Retinal fundus photograph
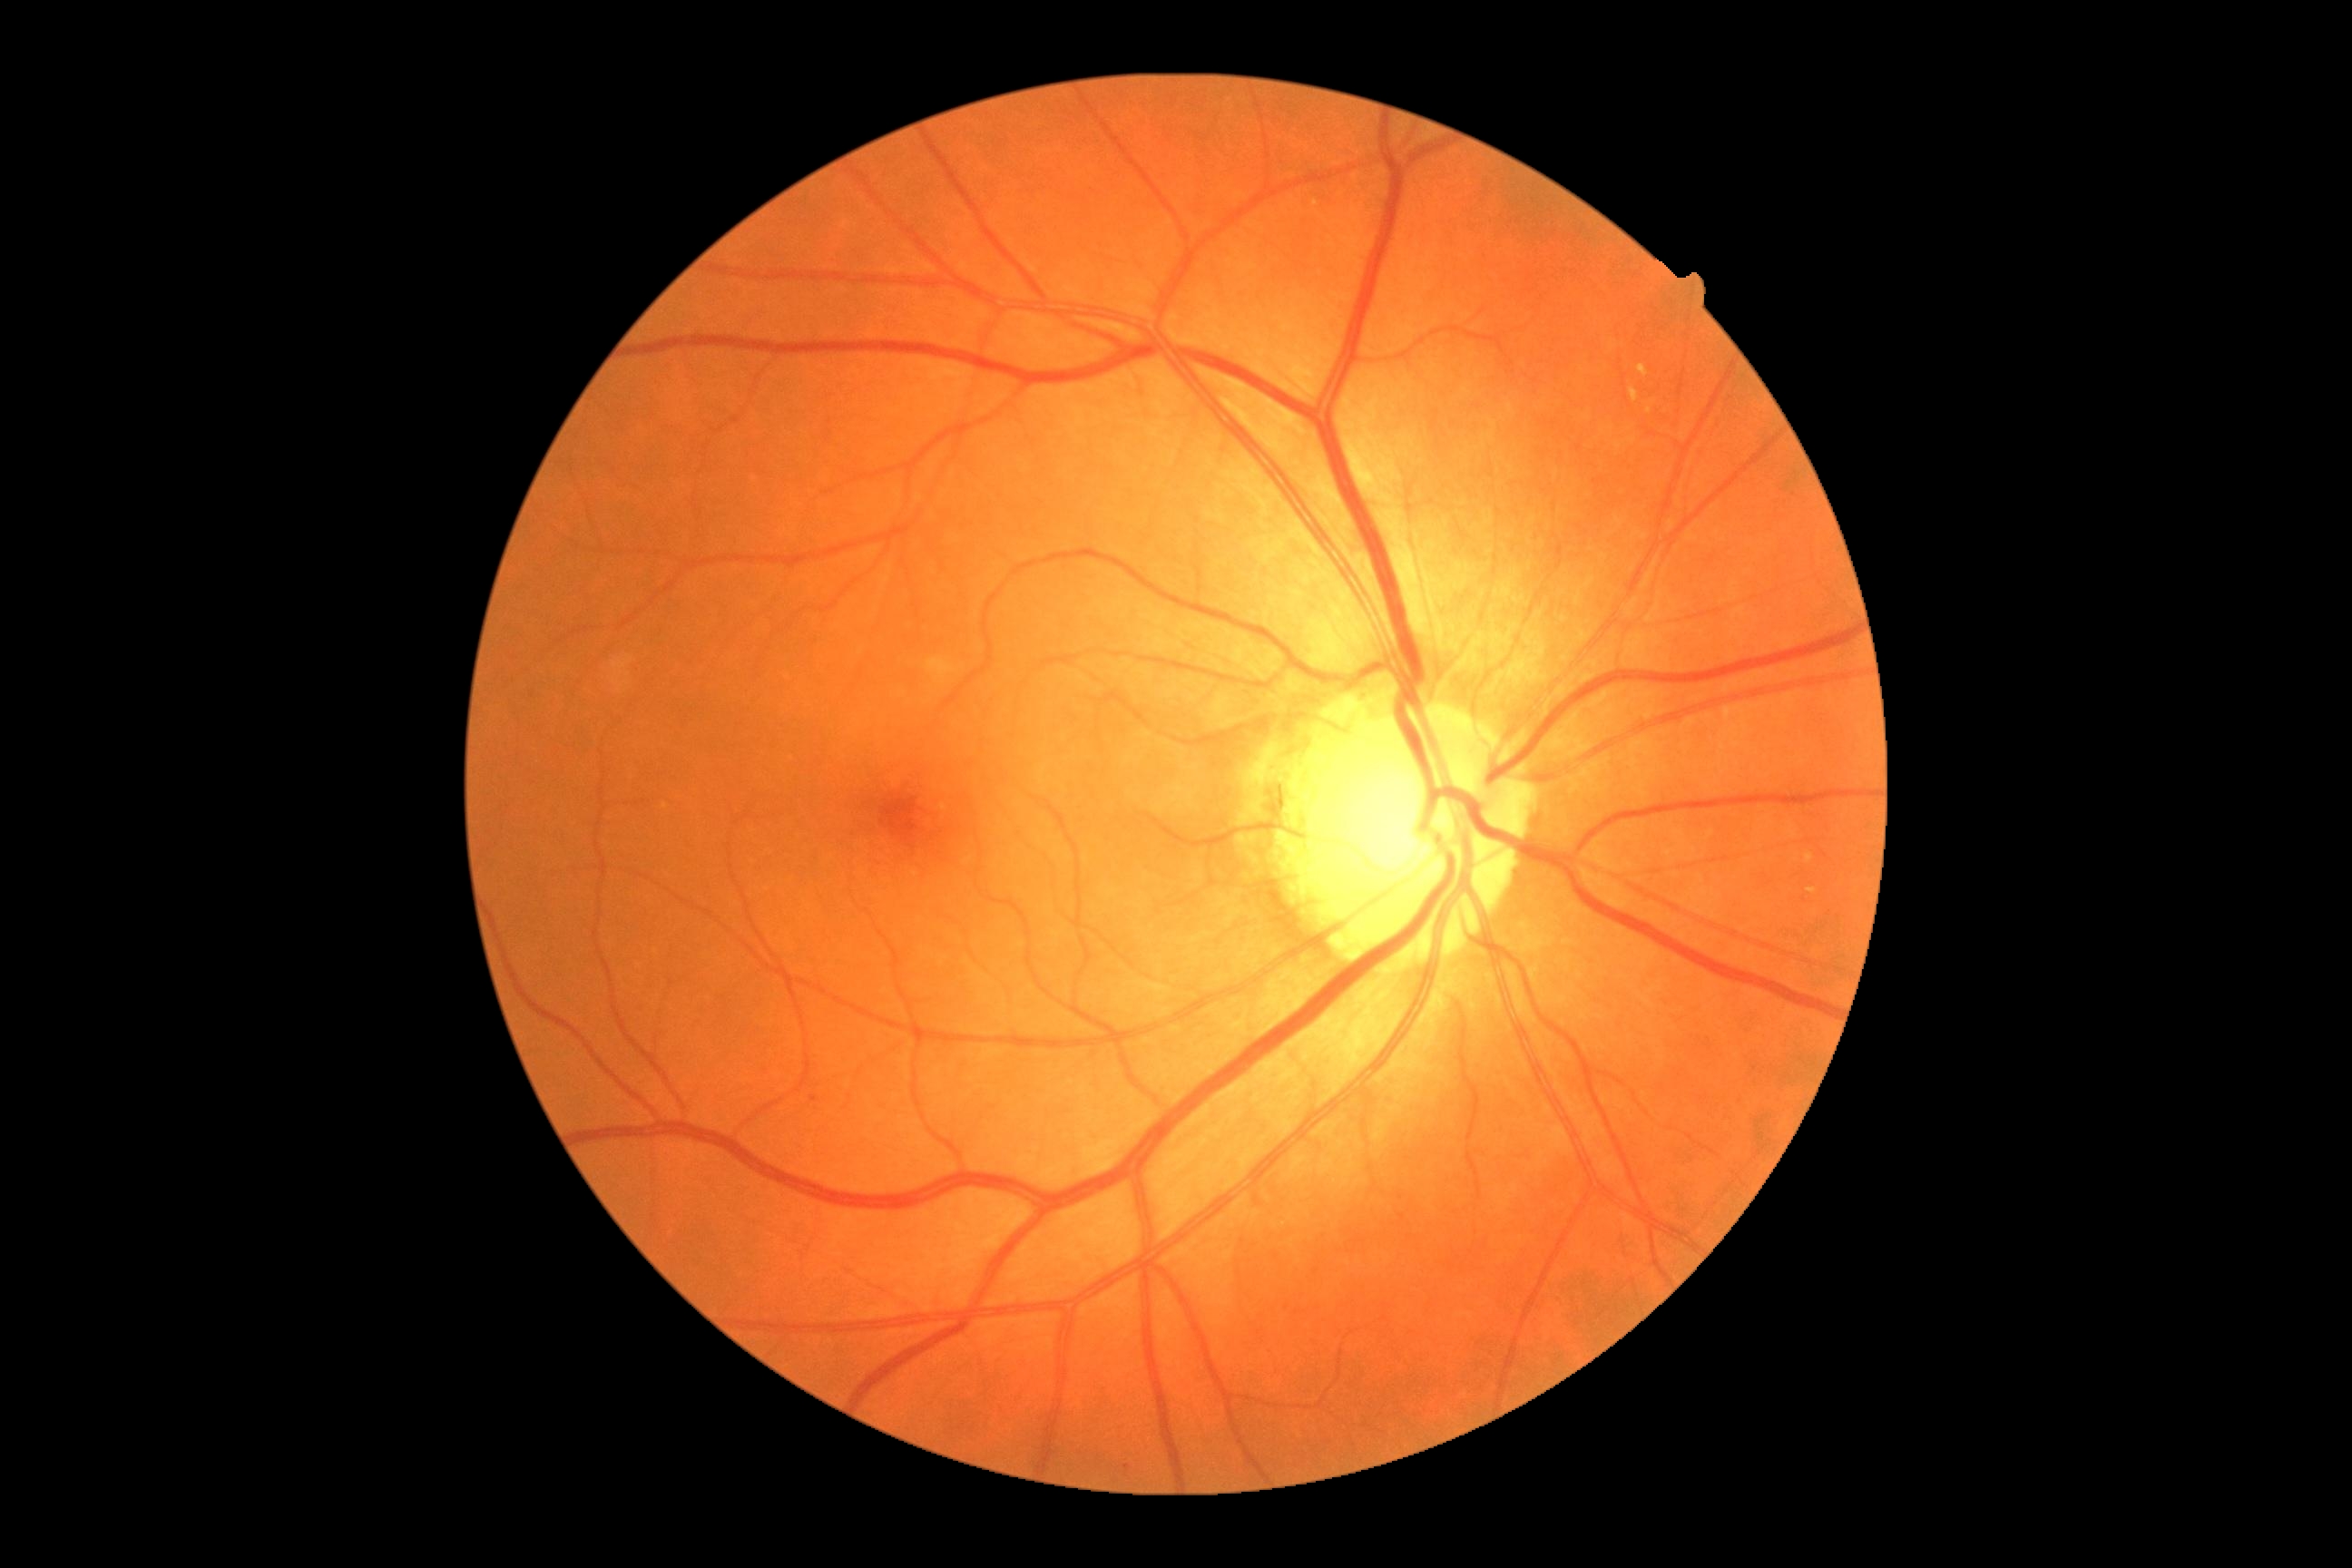 Disease class: non-proliferative diabetic retinopathy. Diabetic retinopathy (DR): 2/4 — more than just microaneurysms but less than severe NPDR.